Image size 1659x2212:
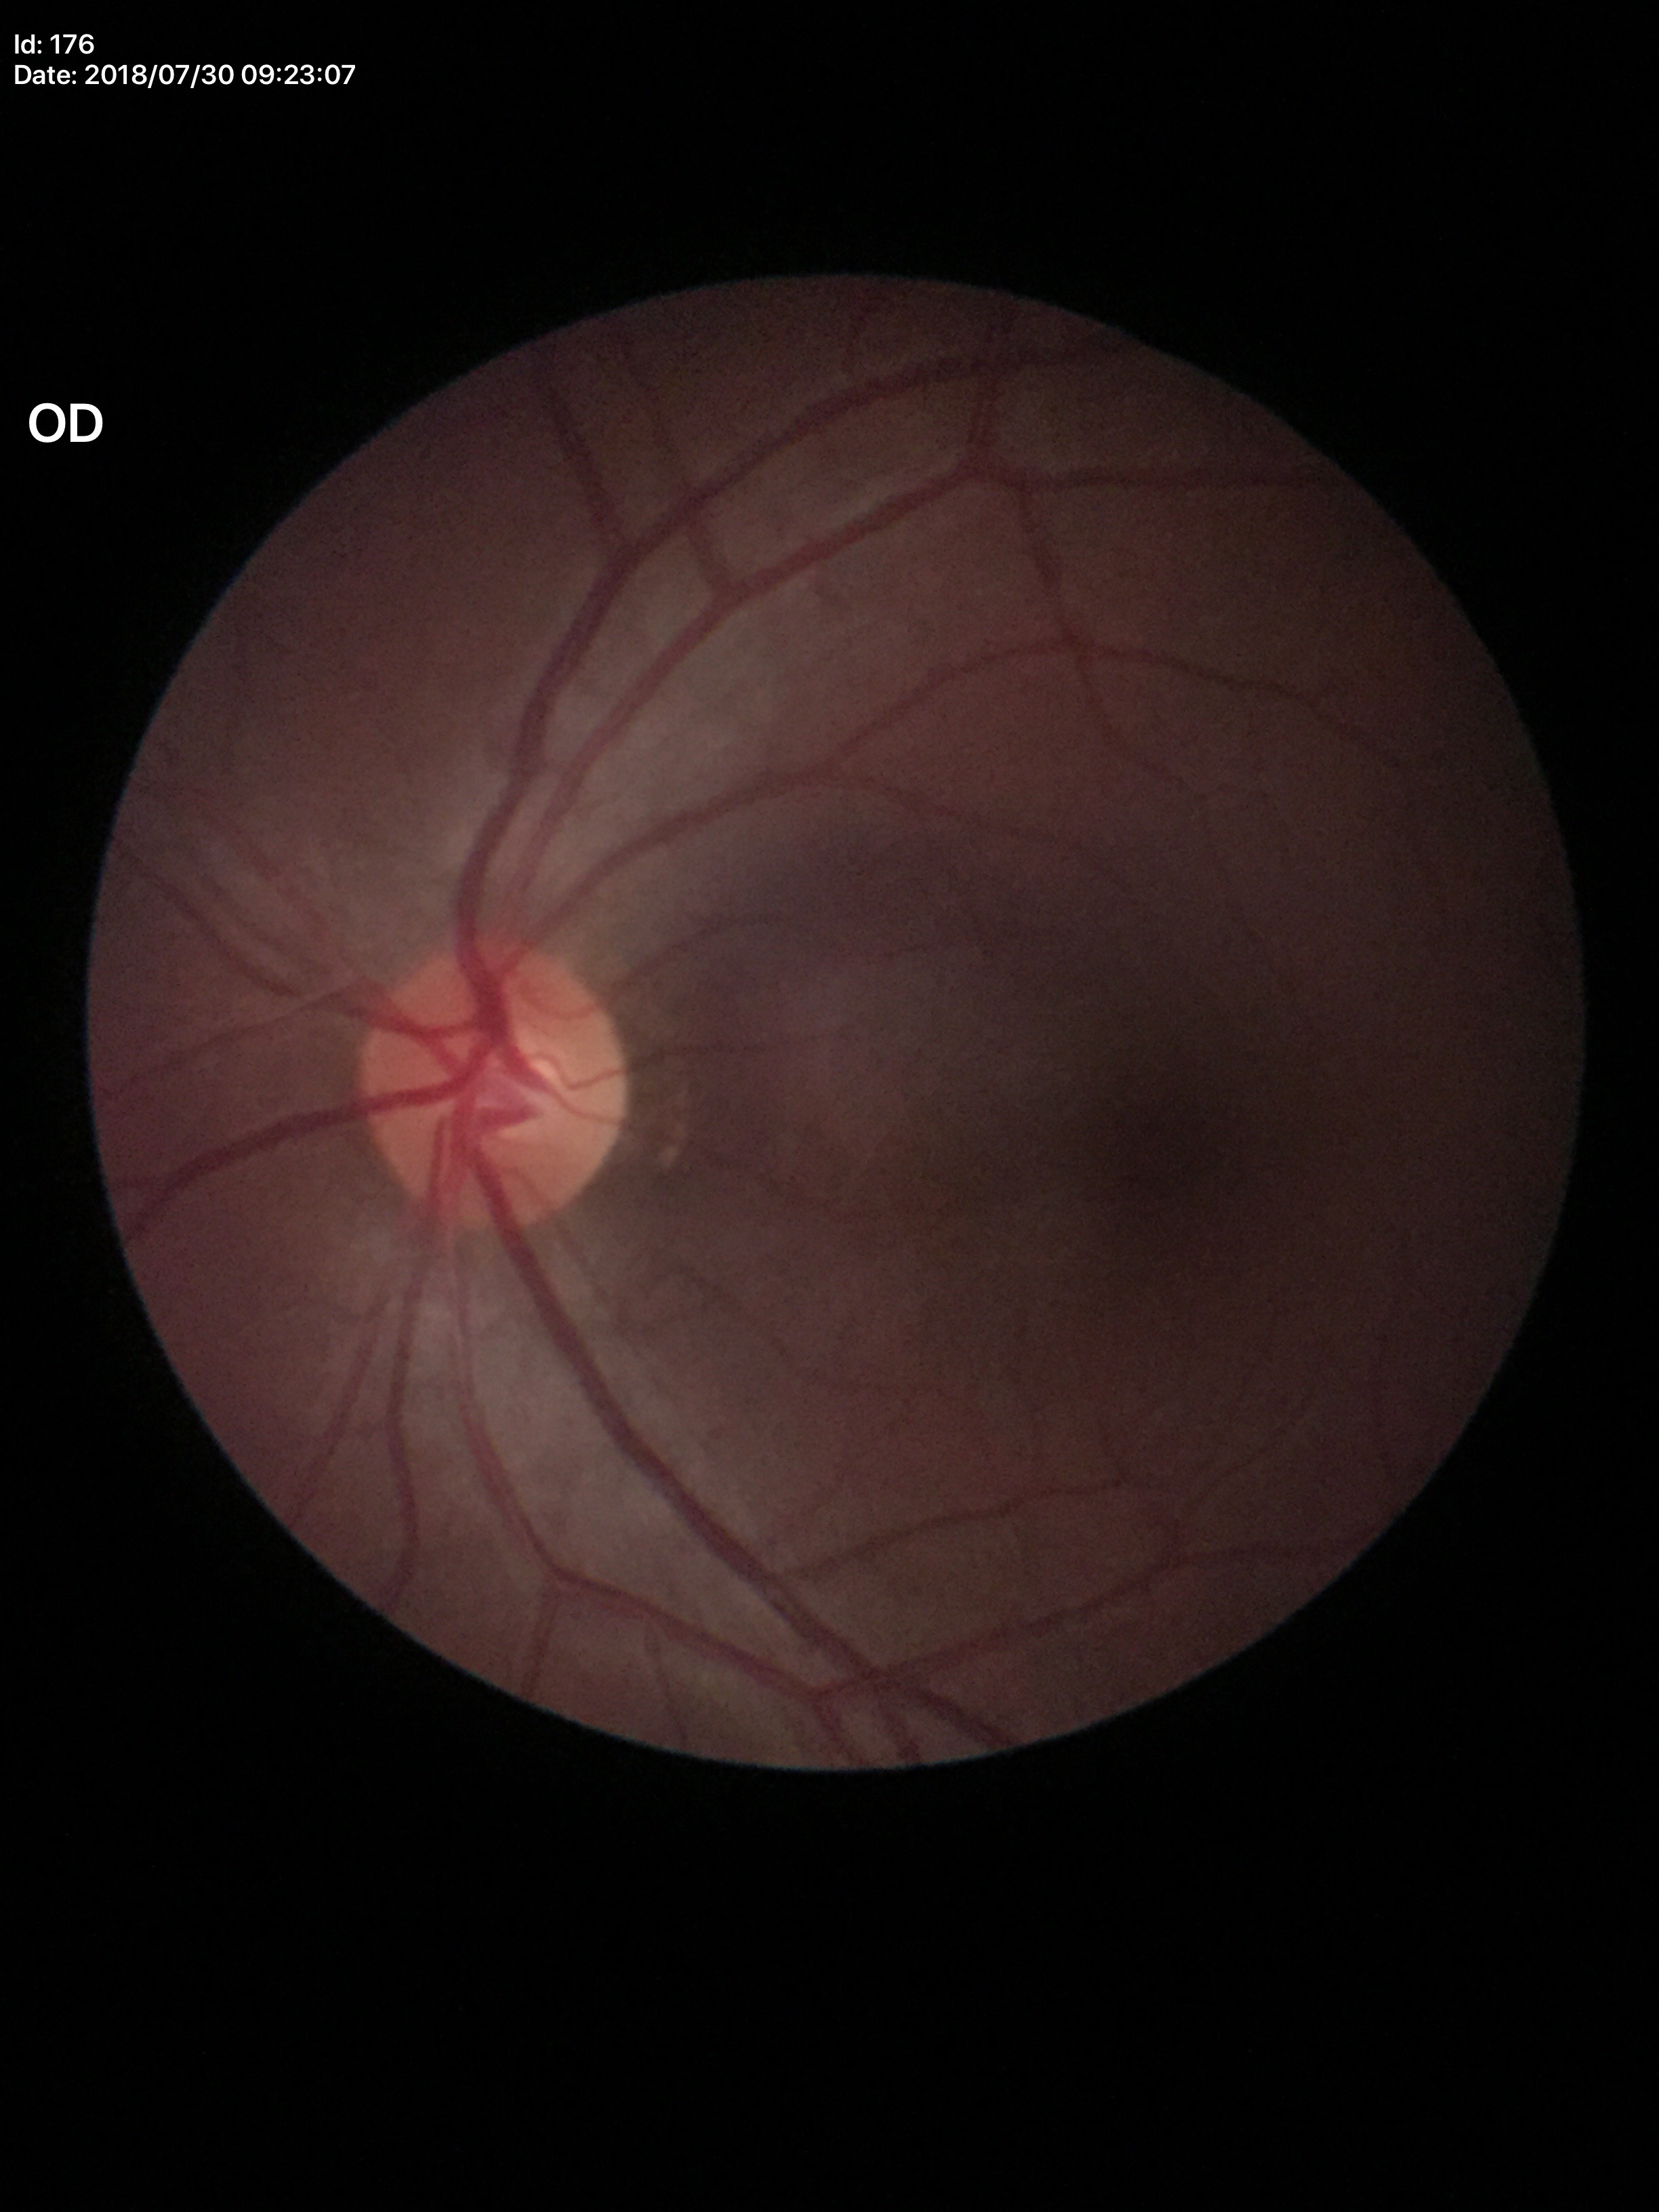
Glaucoma impression = no suspicious findings (unanimous normal call), VCDR = 0.47, HCDR = 0.46.